Camera: Nidek AFC-330; 240x240px; color fundus photograph:
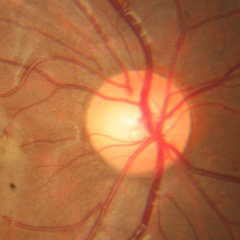

Optic disc appearance consistent with no glaucomatous changes.